FOV: 45 degrees, without pupil dilation, retinal fundus photograph, acquired with a NIDEK AFC-230:
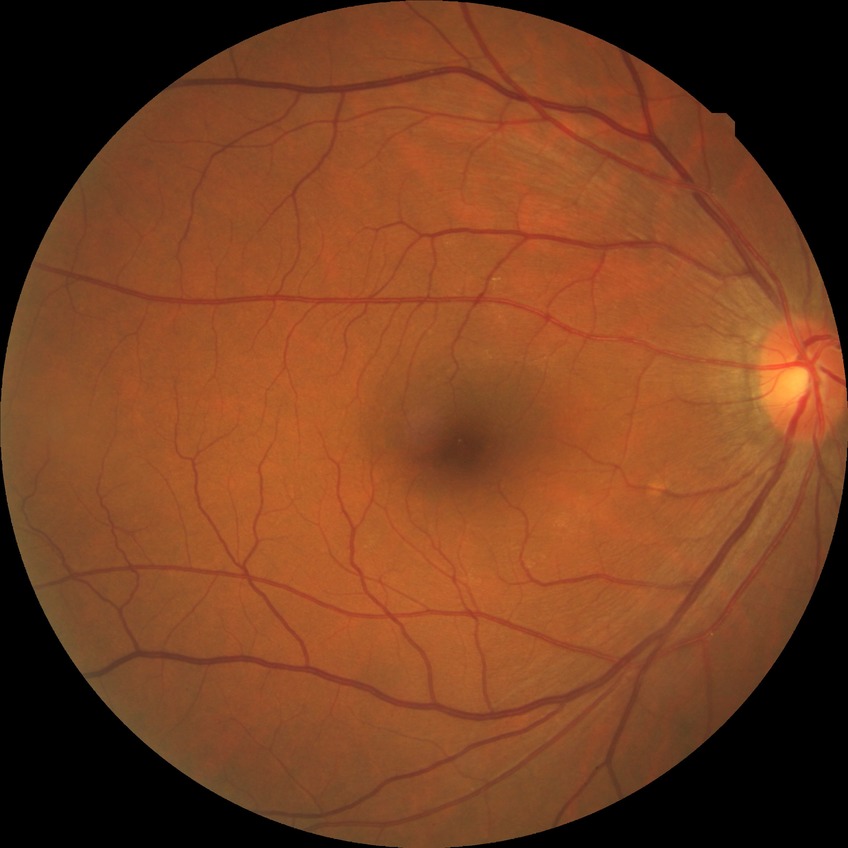 Diabetic retinopathy (DR) is NDR (no diabetic retinopathy).